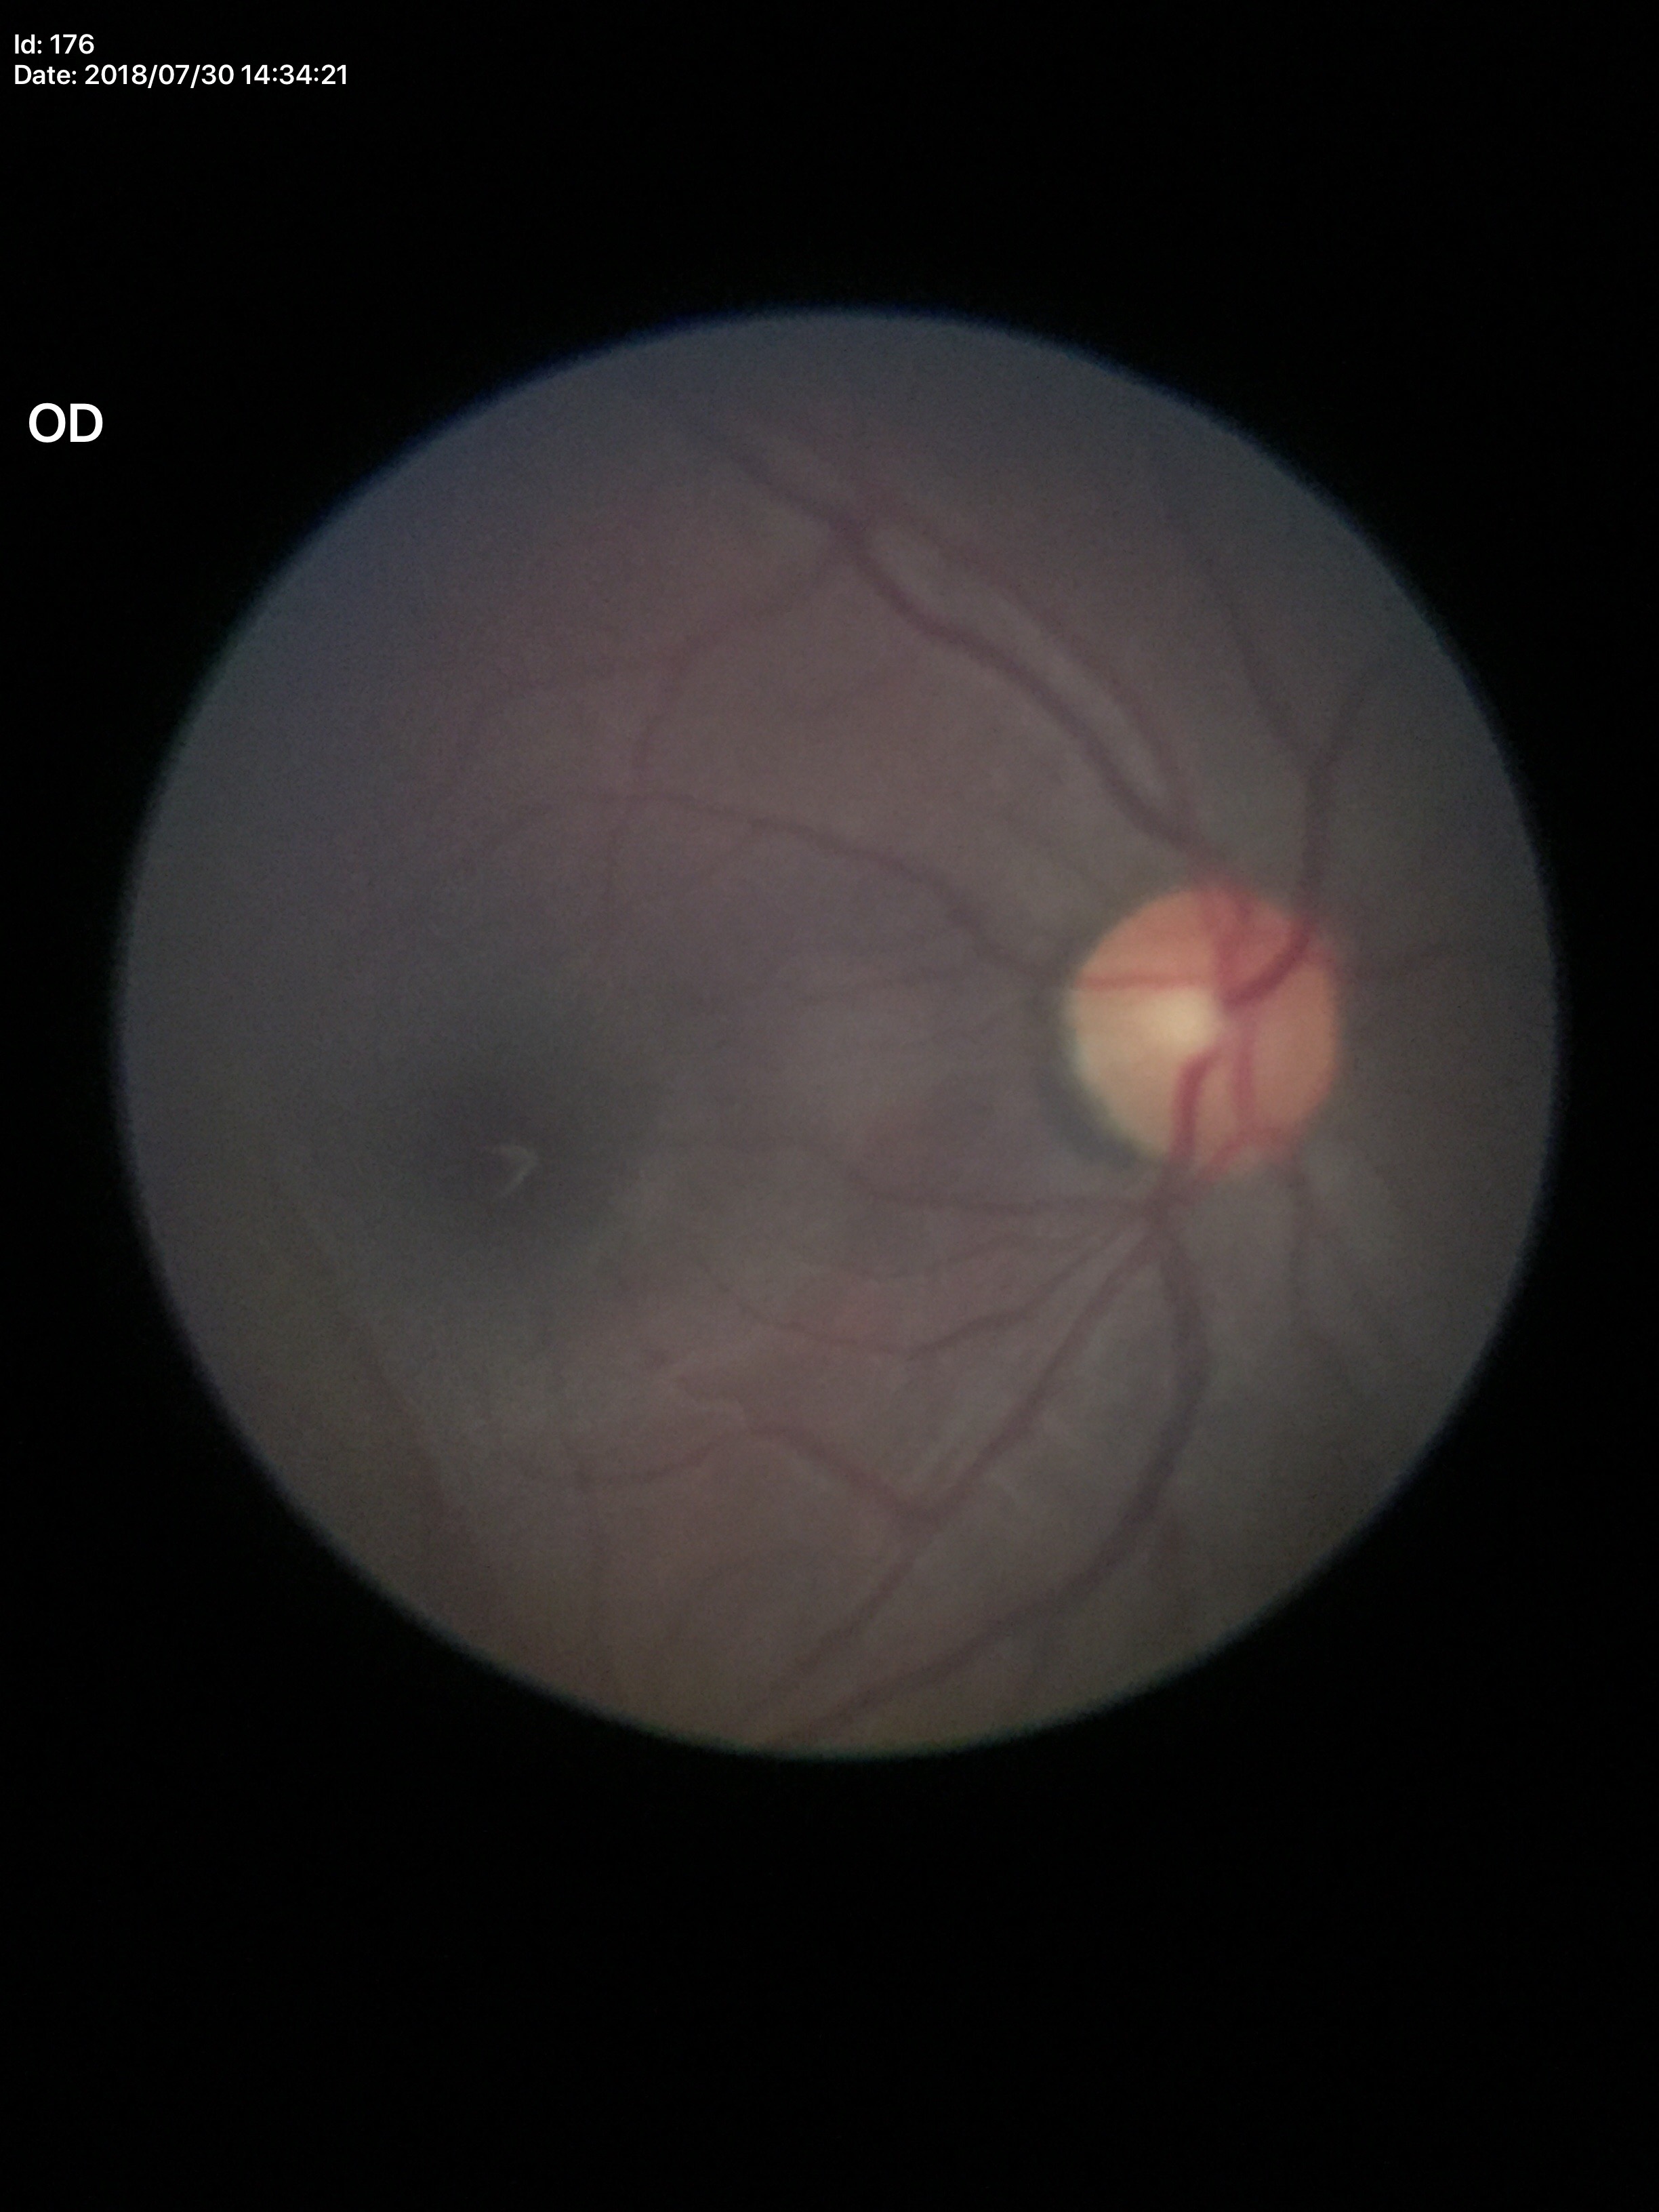
Glaucoma decision = no suspicious findings | VCDR = 0.42.